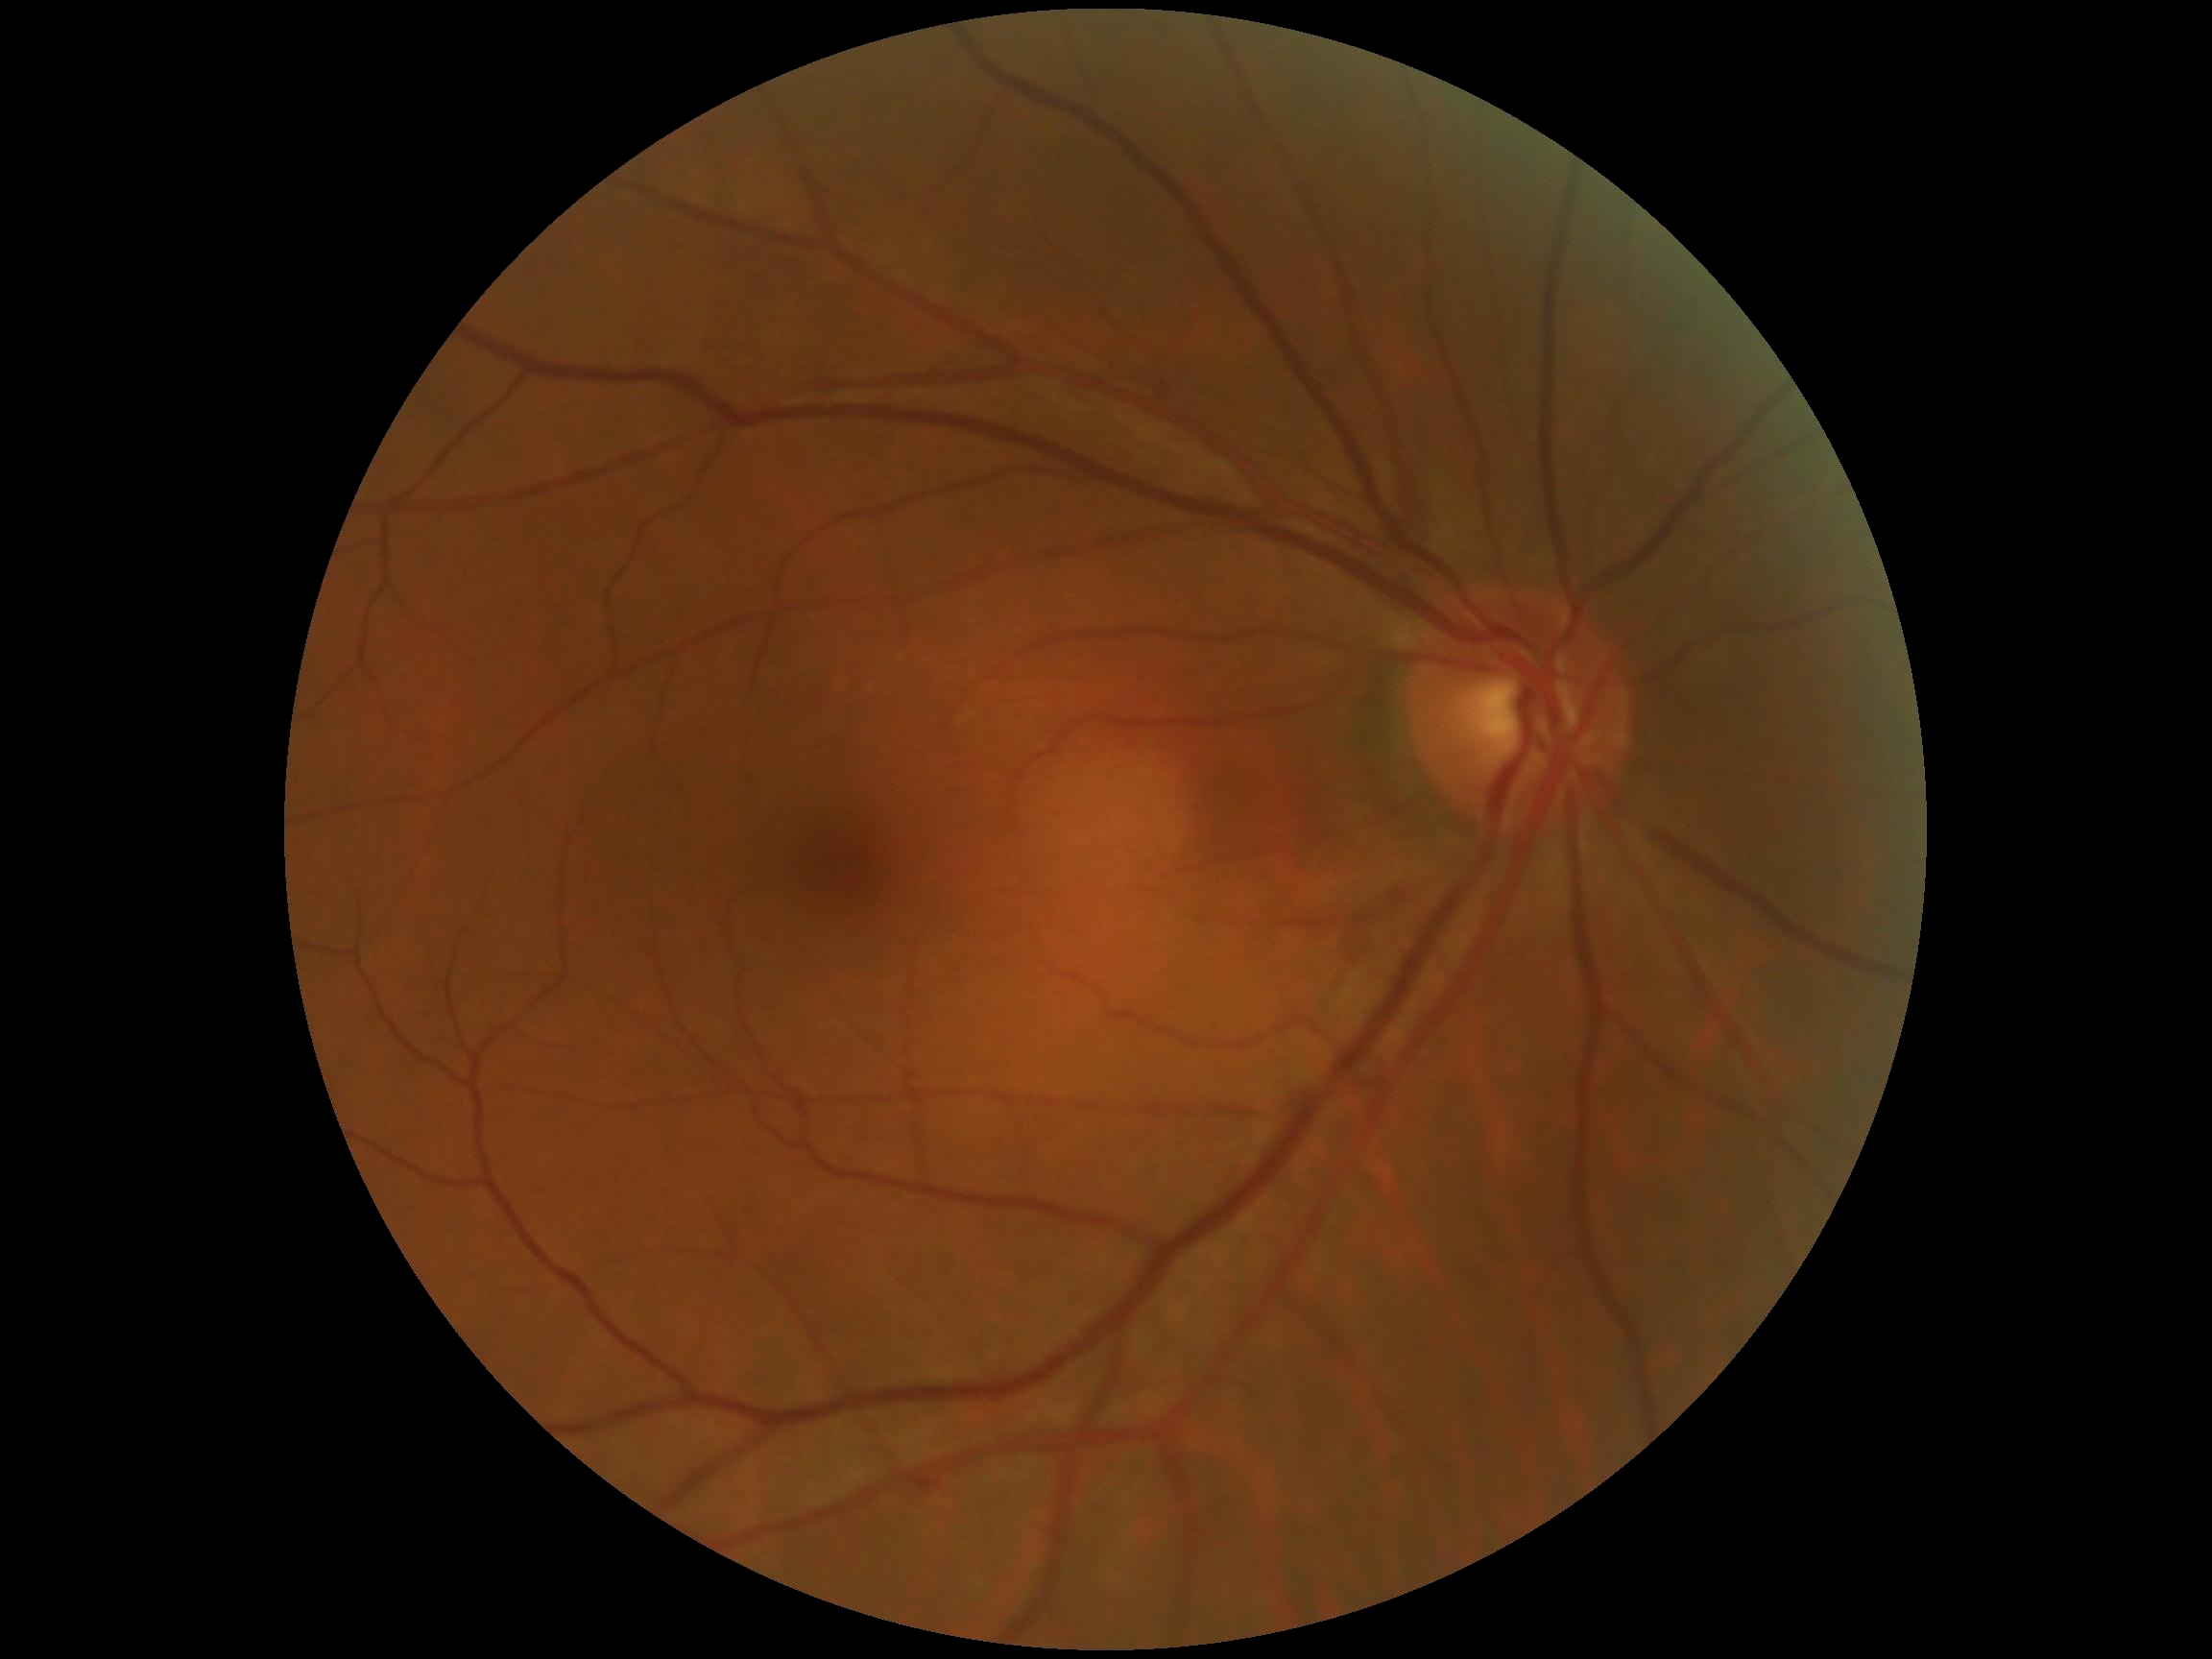
DR grade is no apparent retinopathy (0) — no visible signs of diabetic retinopathy.